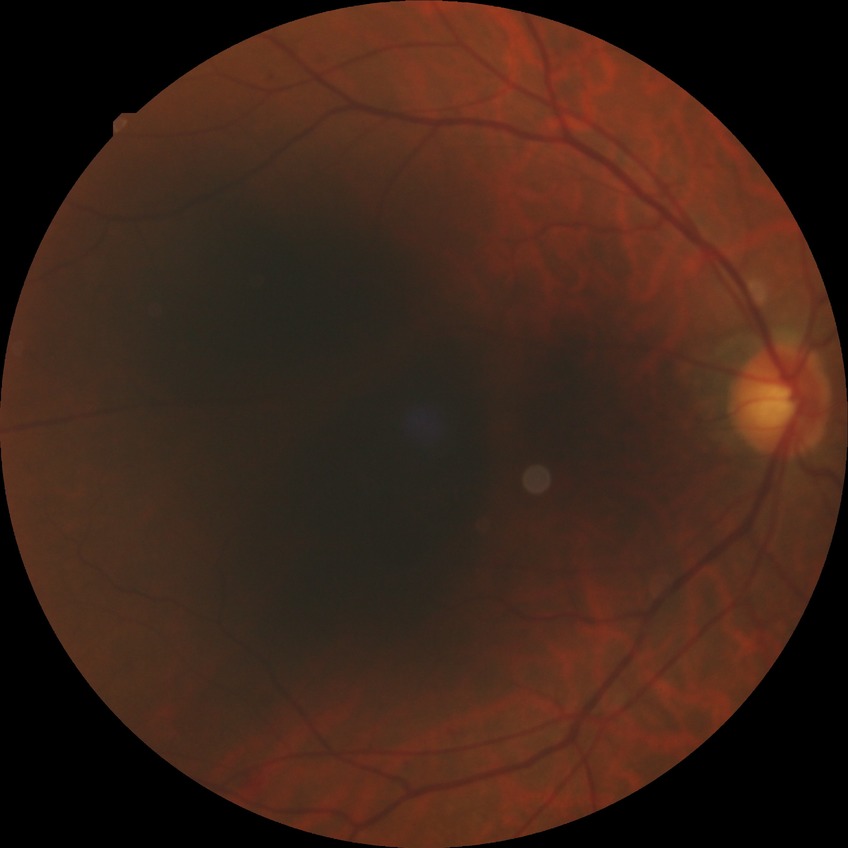
modified Davis classification: simple diabetic retinopathy.